1440 by 1080 pixels · infant wide-field fundus photograph · captured with the Natus RetCam Envision (130° field of view) — 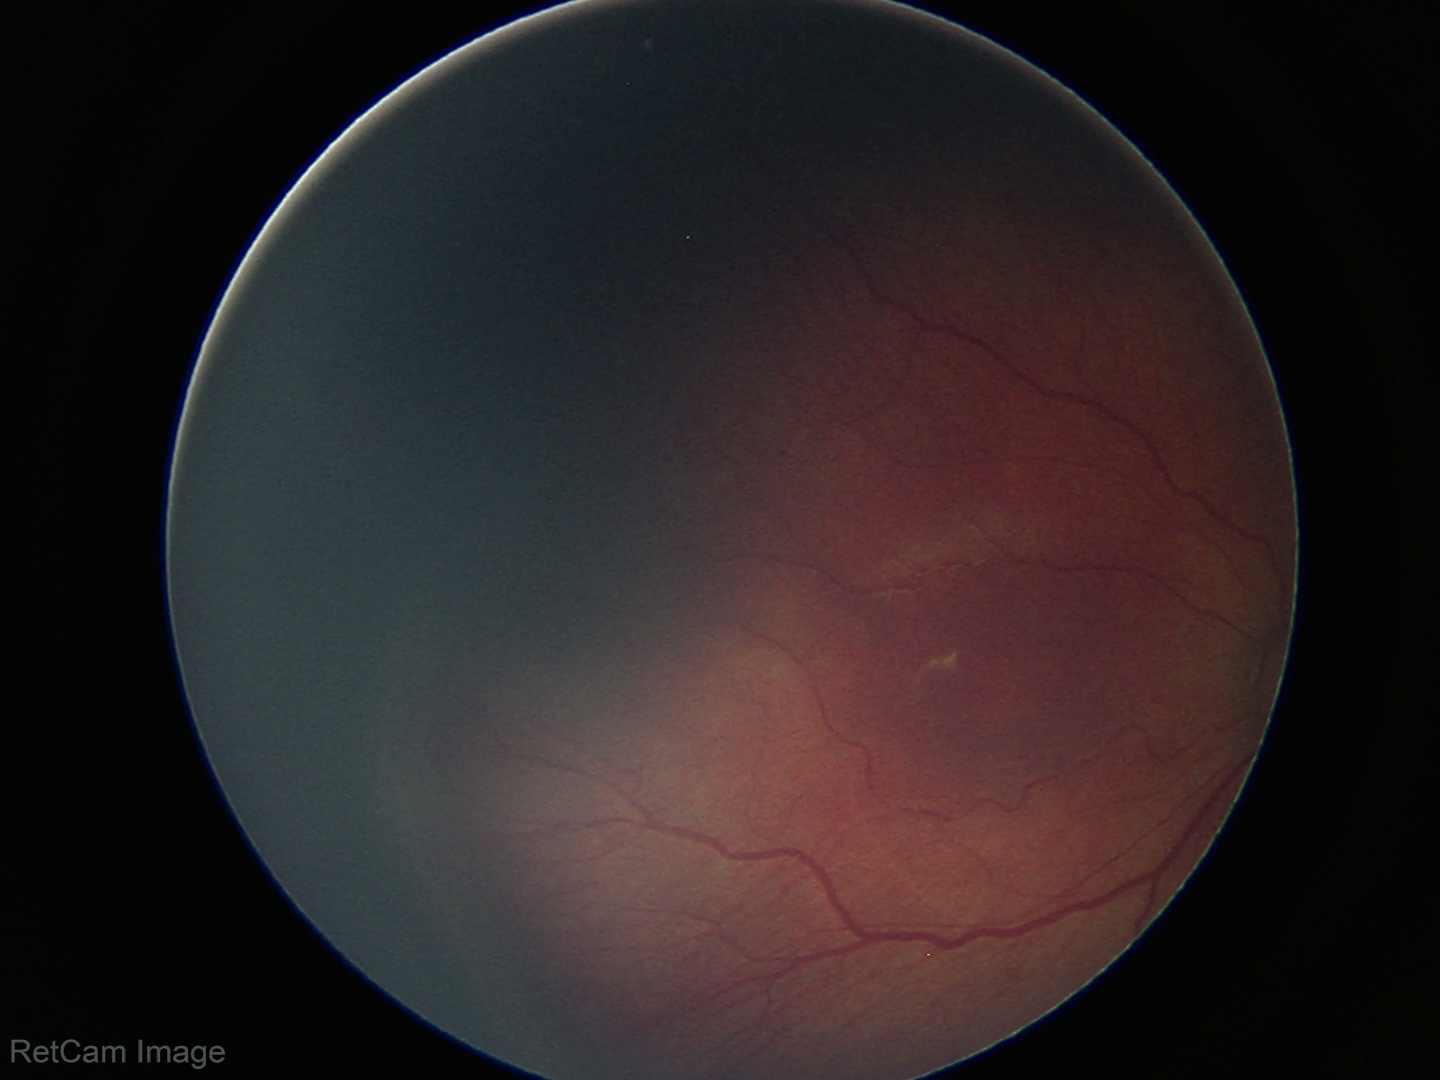

Assessment = retinopathy of prematurity (ROP) stage 3